Wide-field contact fundus photograph of an infant; 130° field of view (Clarity RetCam 3); image size 640x480
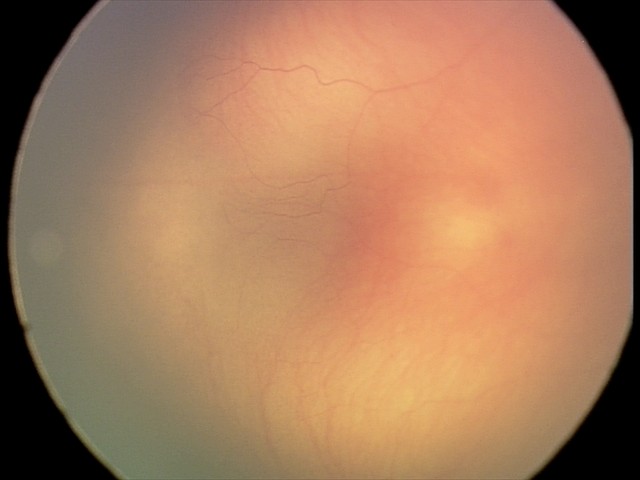
Q: Is plus disease present?
A: no plus disease
Q: What is the screening diagnosis?
A: retinopathy of prematurity (ROP) stage 1